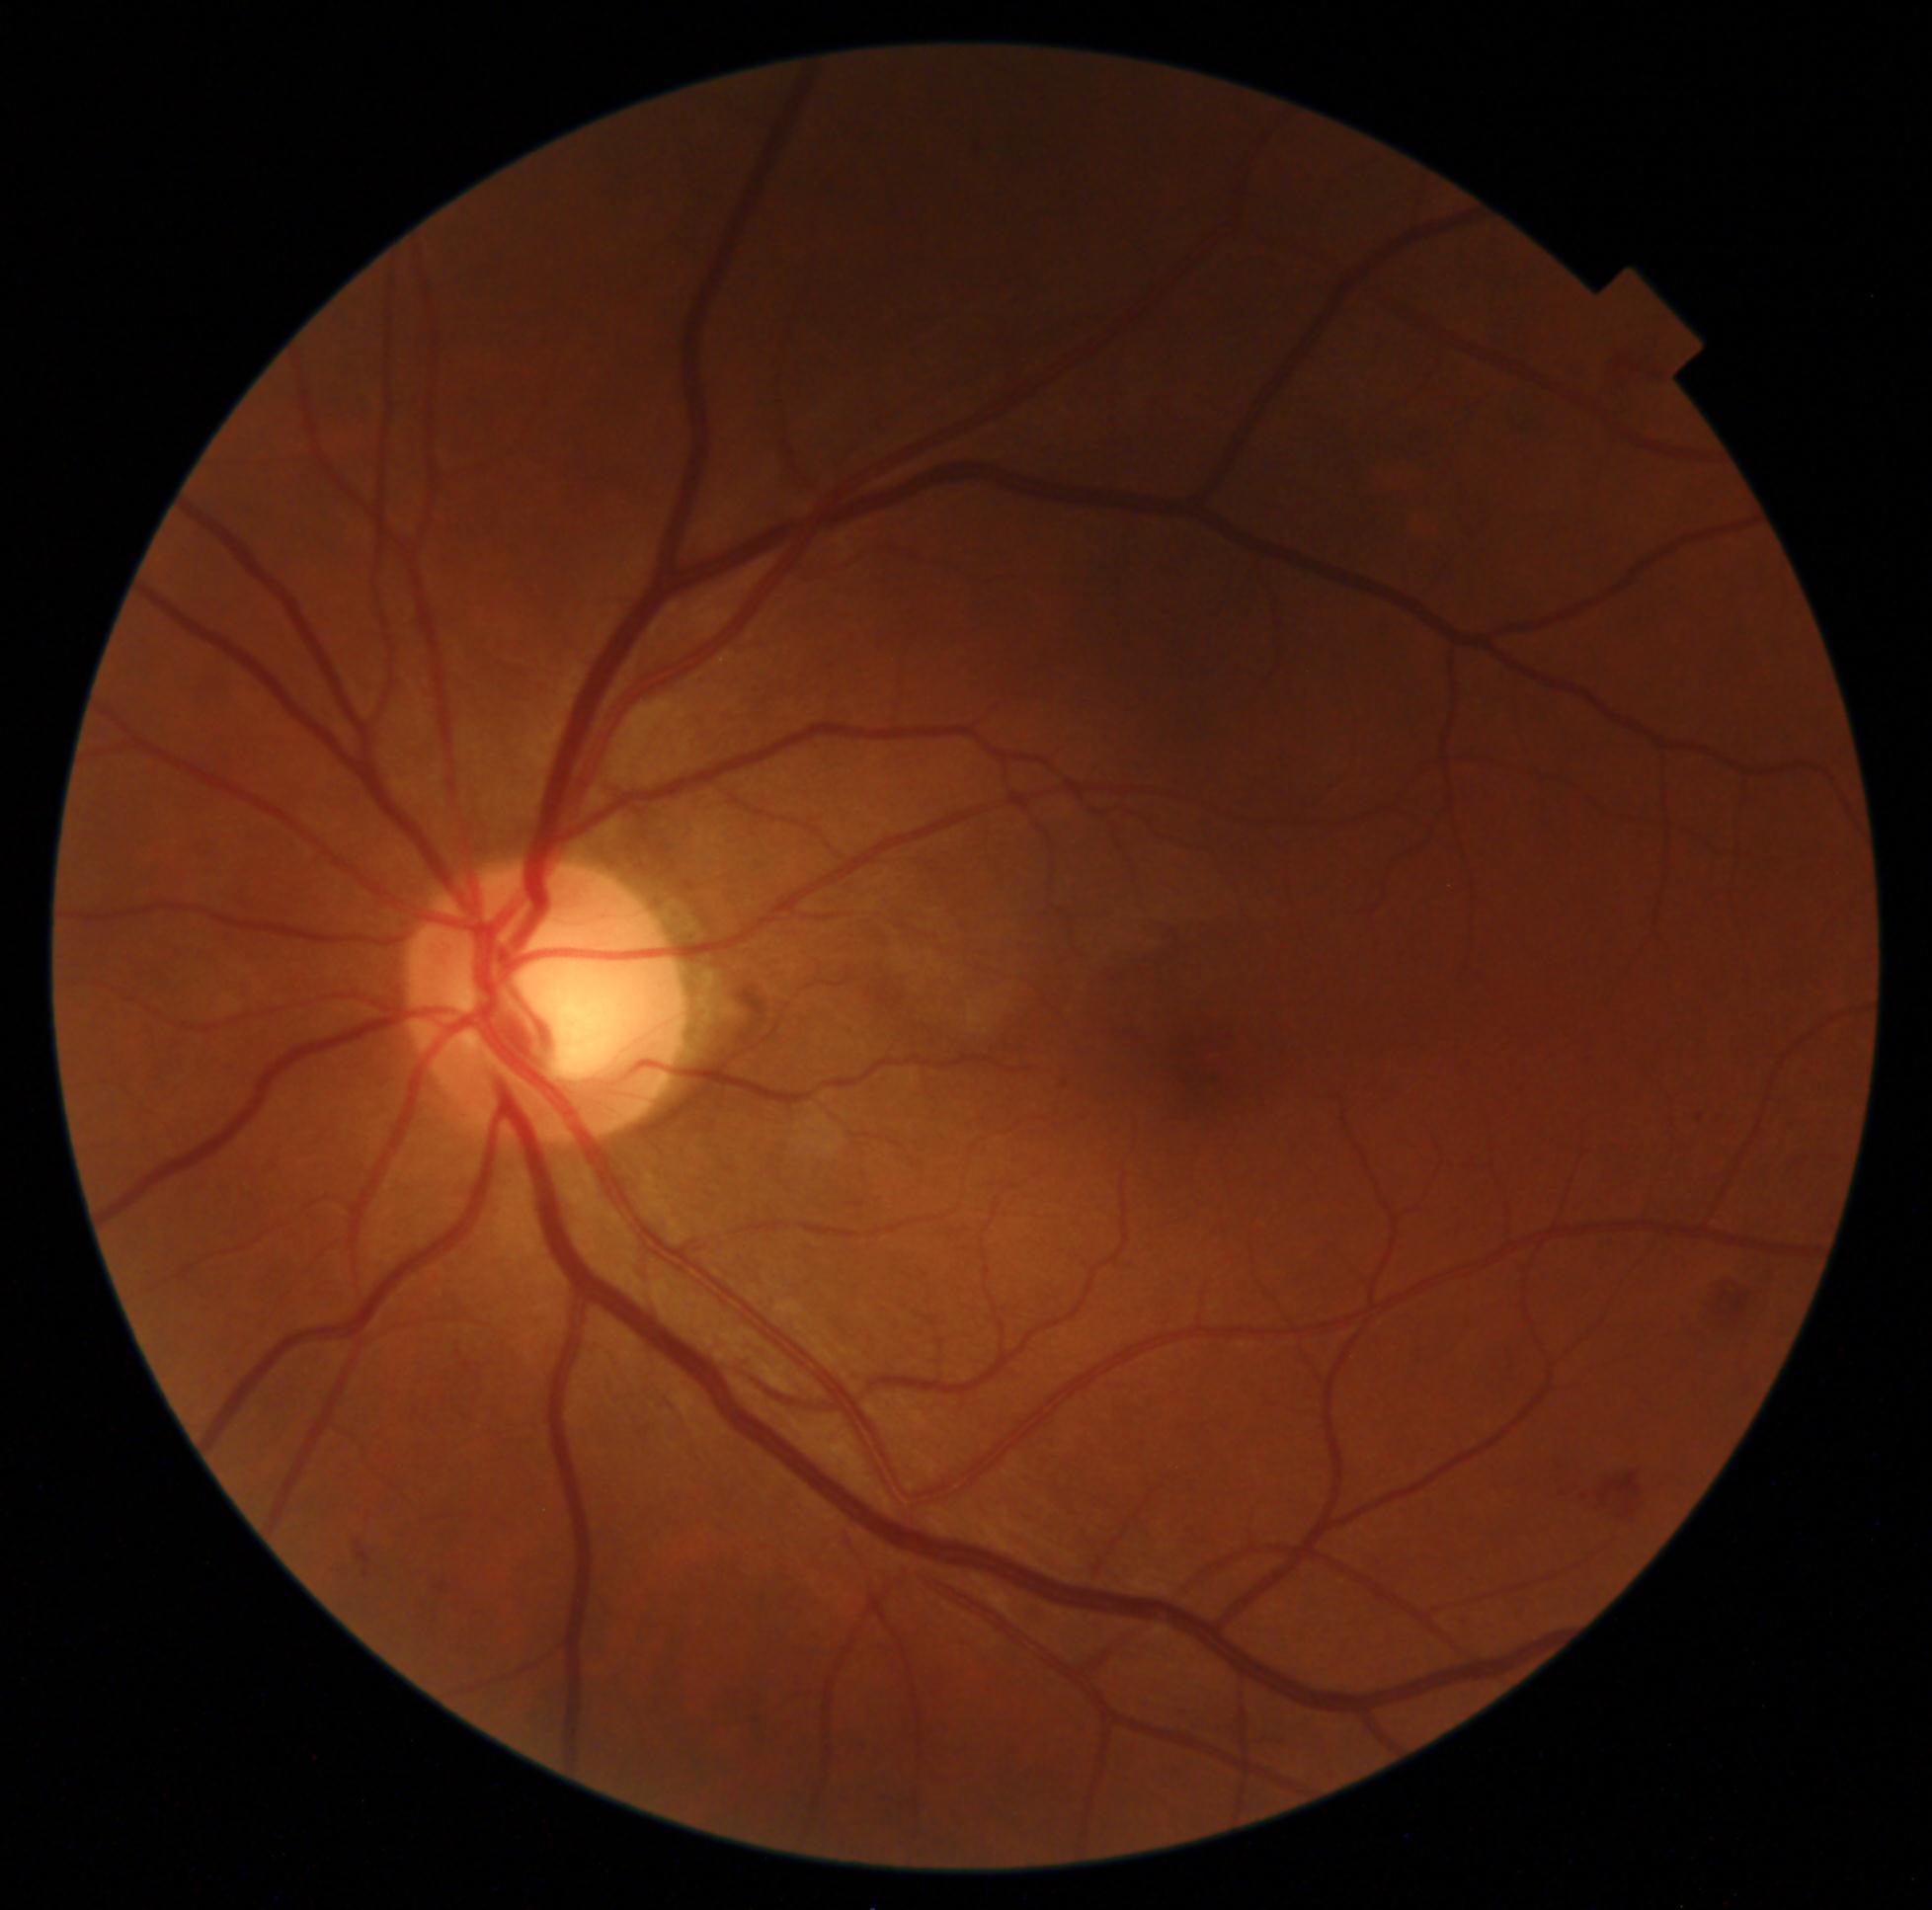
DR severity: grade 2.
DR class: non-proliferative diabetic retinopathy.